Fundus photo; 2352x1568 — 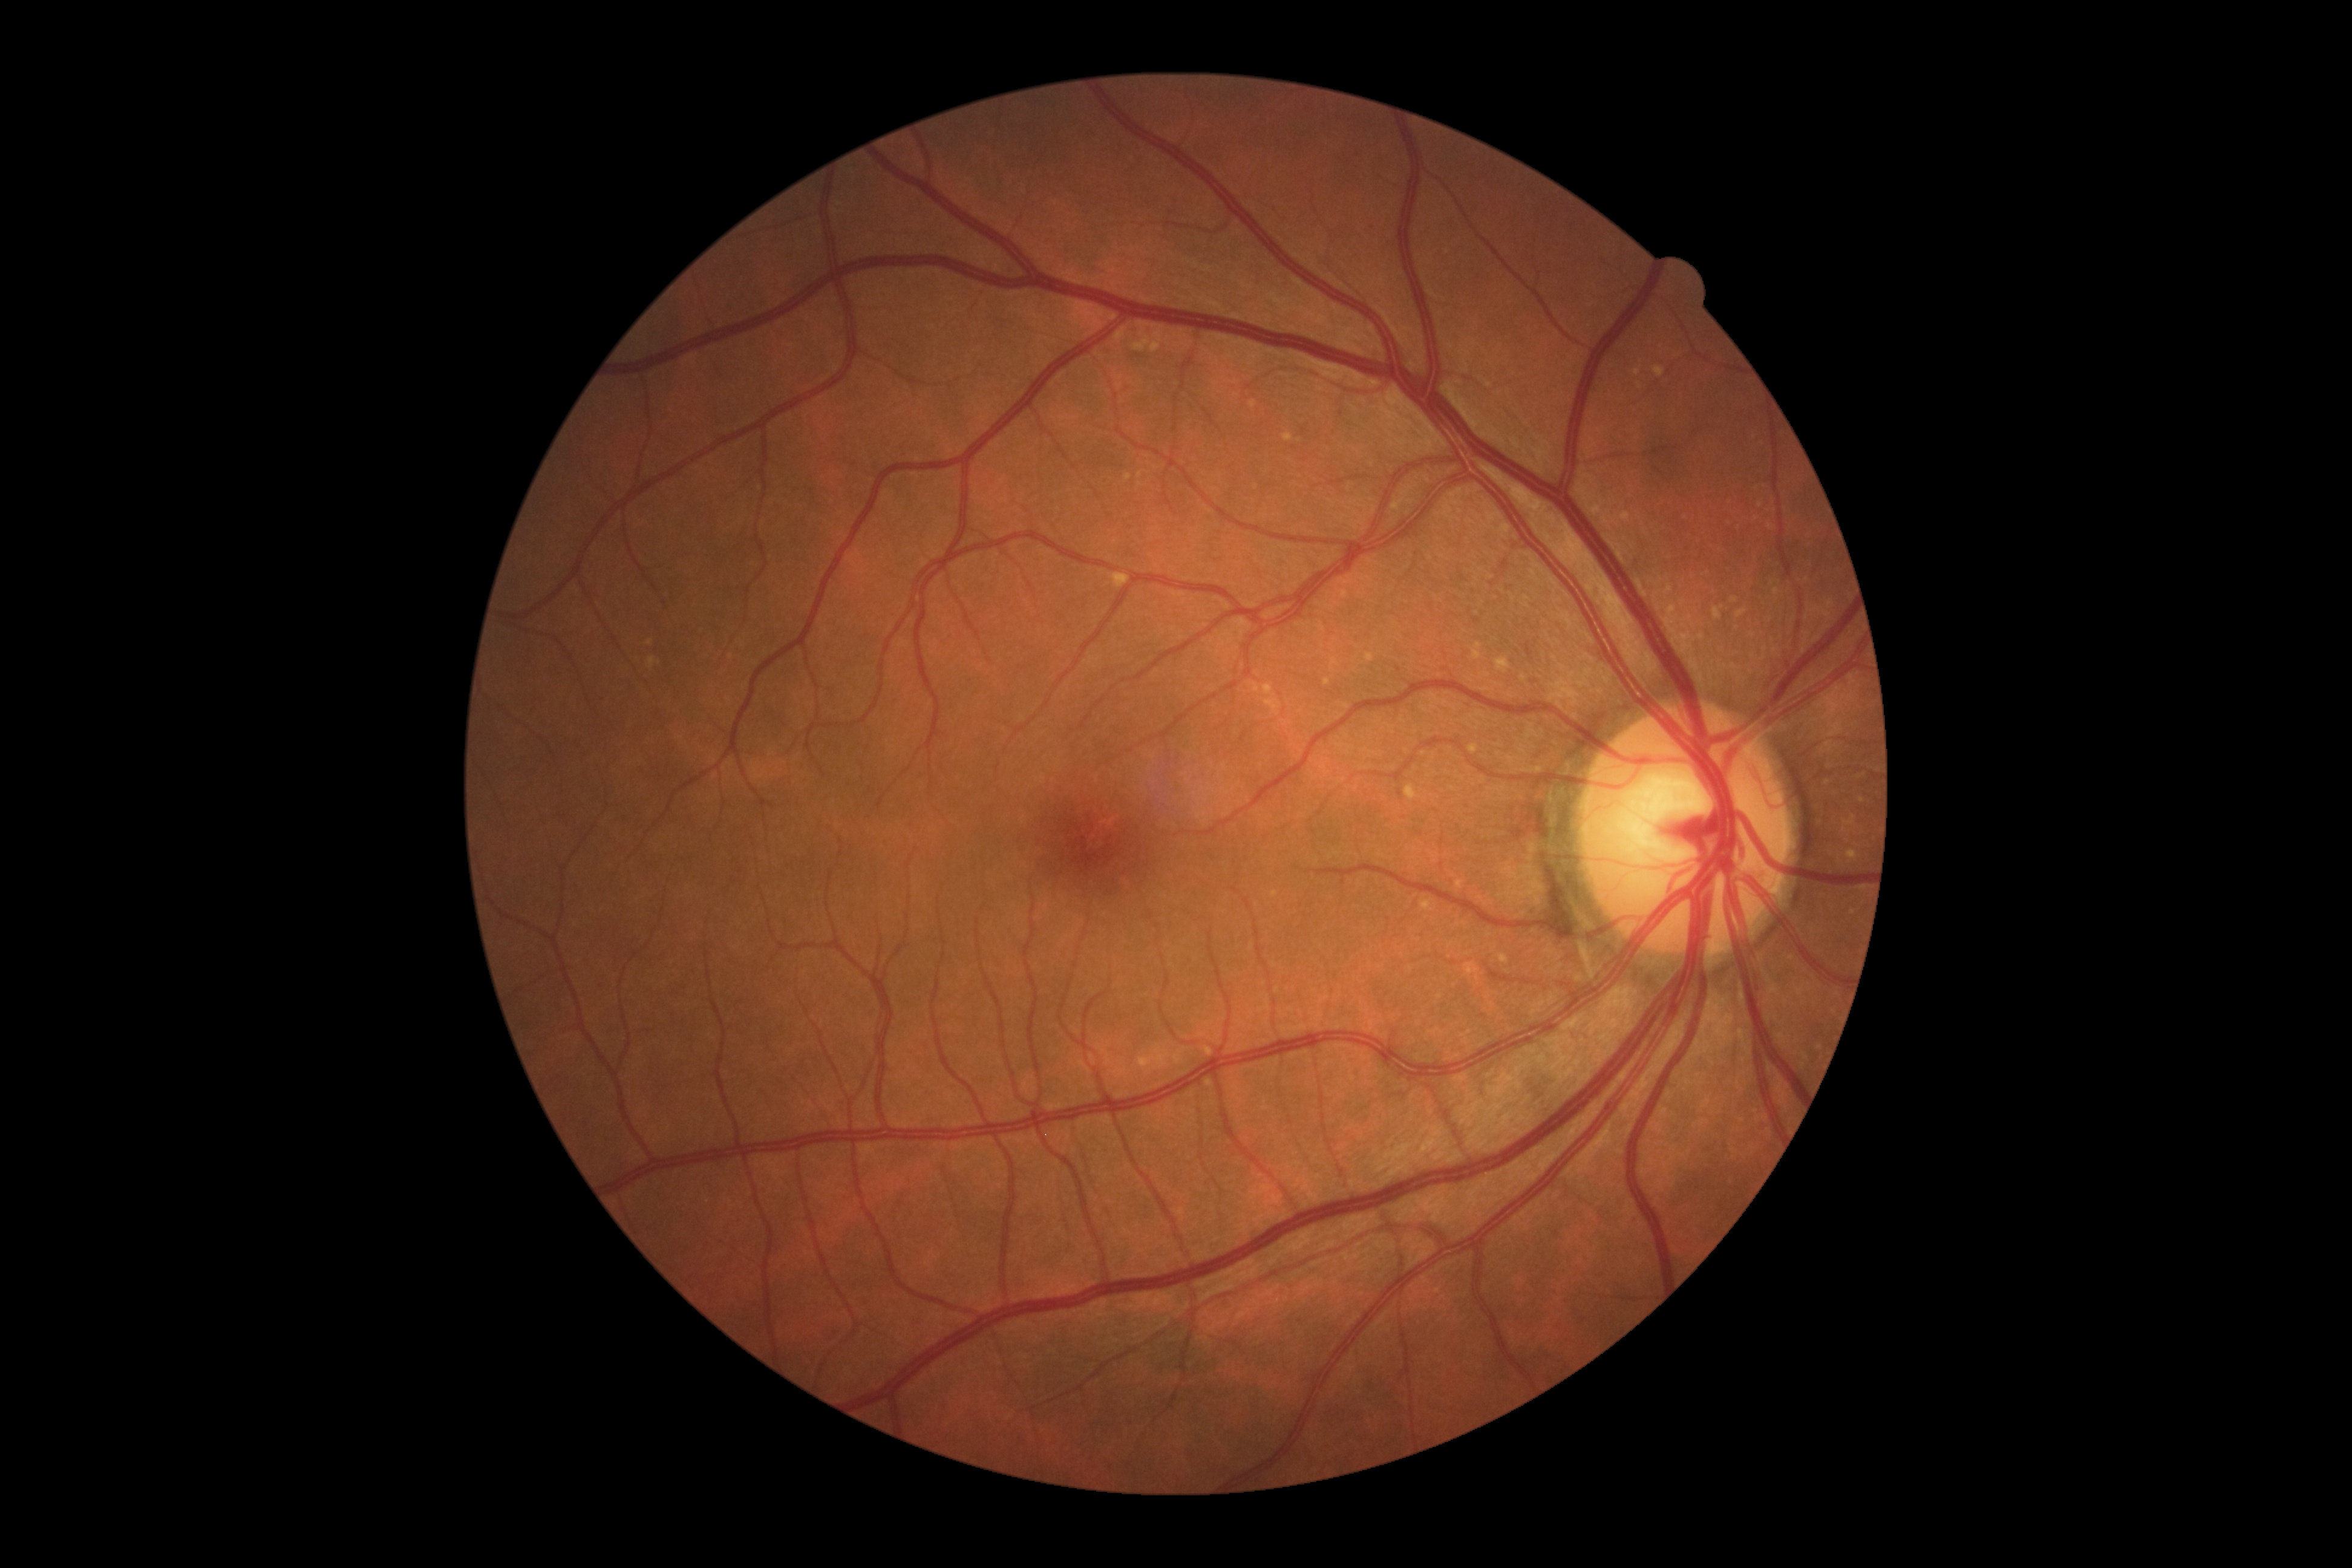   dr_grade: grade 0 (no apparent retinopathy)
  dr_impression: no signs of DR